Infant wide-field fundus photograph — 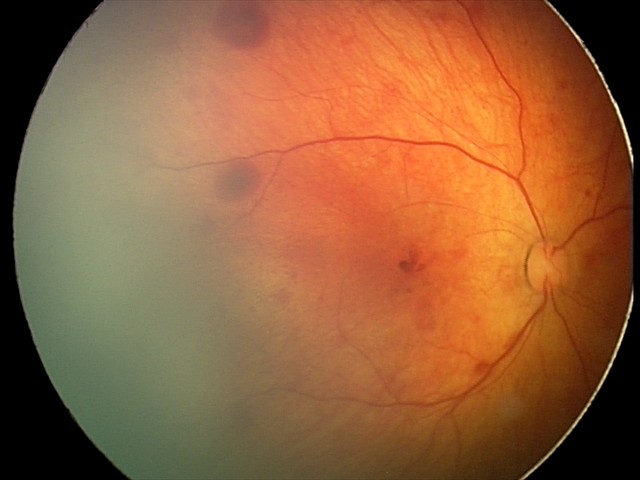

Assessment: retinal hemorrhages.